Color fundus image · modified Davis grading · 45-degree field of view: 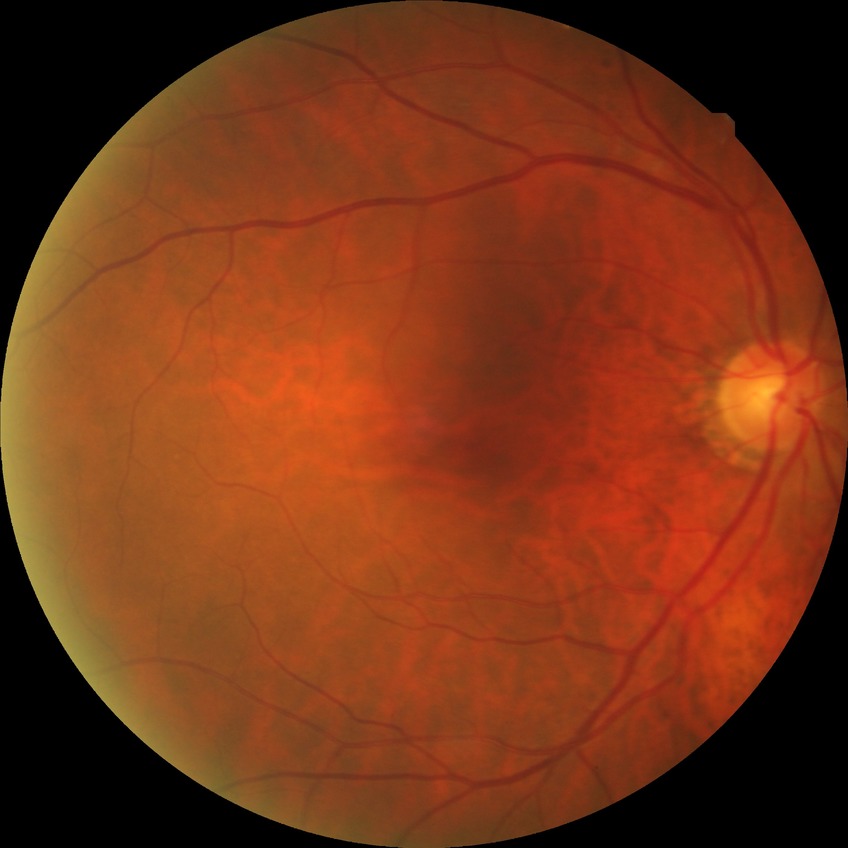
Assessment:
• modified Davis grading — no diabetic retinopathy